Acquired on the Clarity RetCam 3 · wide-field contact fundus photograph of an infant · image size 640x480
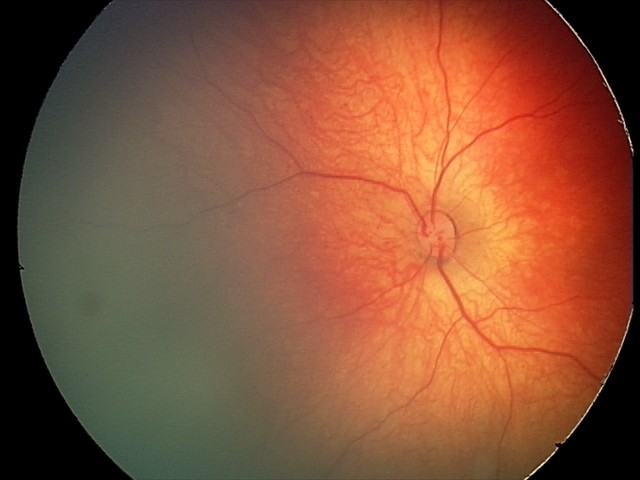

From an examination with diagnosis of retinal hemorrhages.